640x480px · camera: Clarity RetCam 3 (130° FOV) · RetCam wide-field infant fundus image: 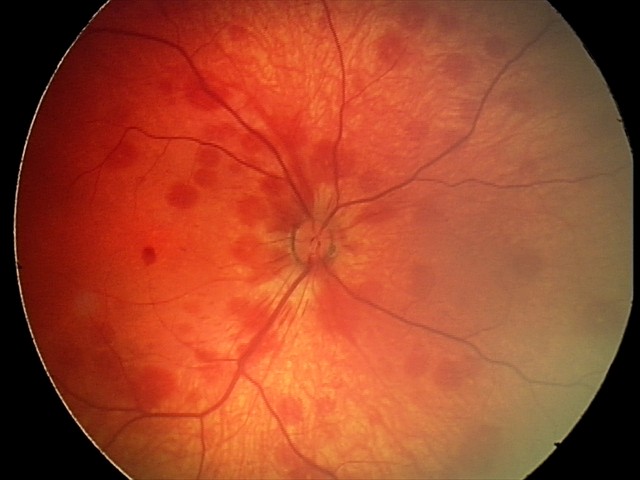
From an examination with diagnosis of retinal hemorrhages.